Retinal fundus photograph.
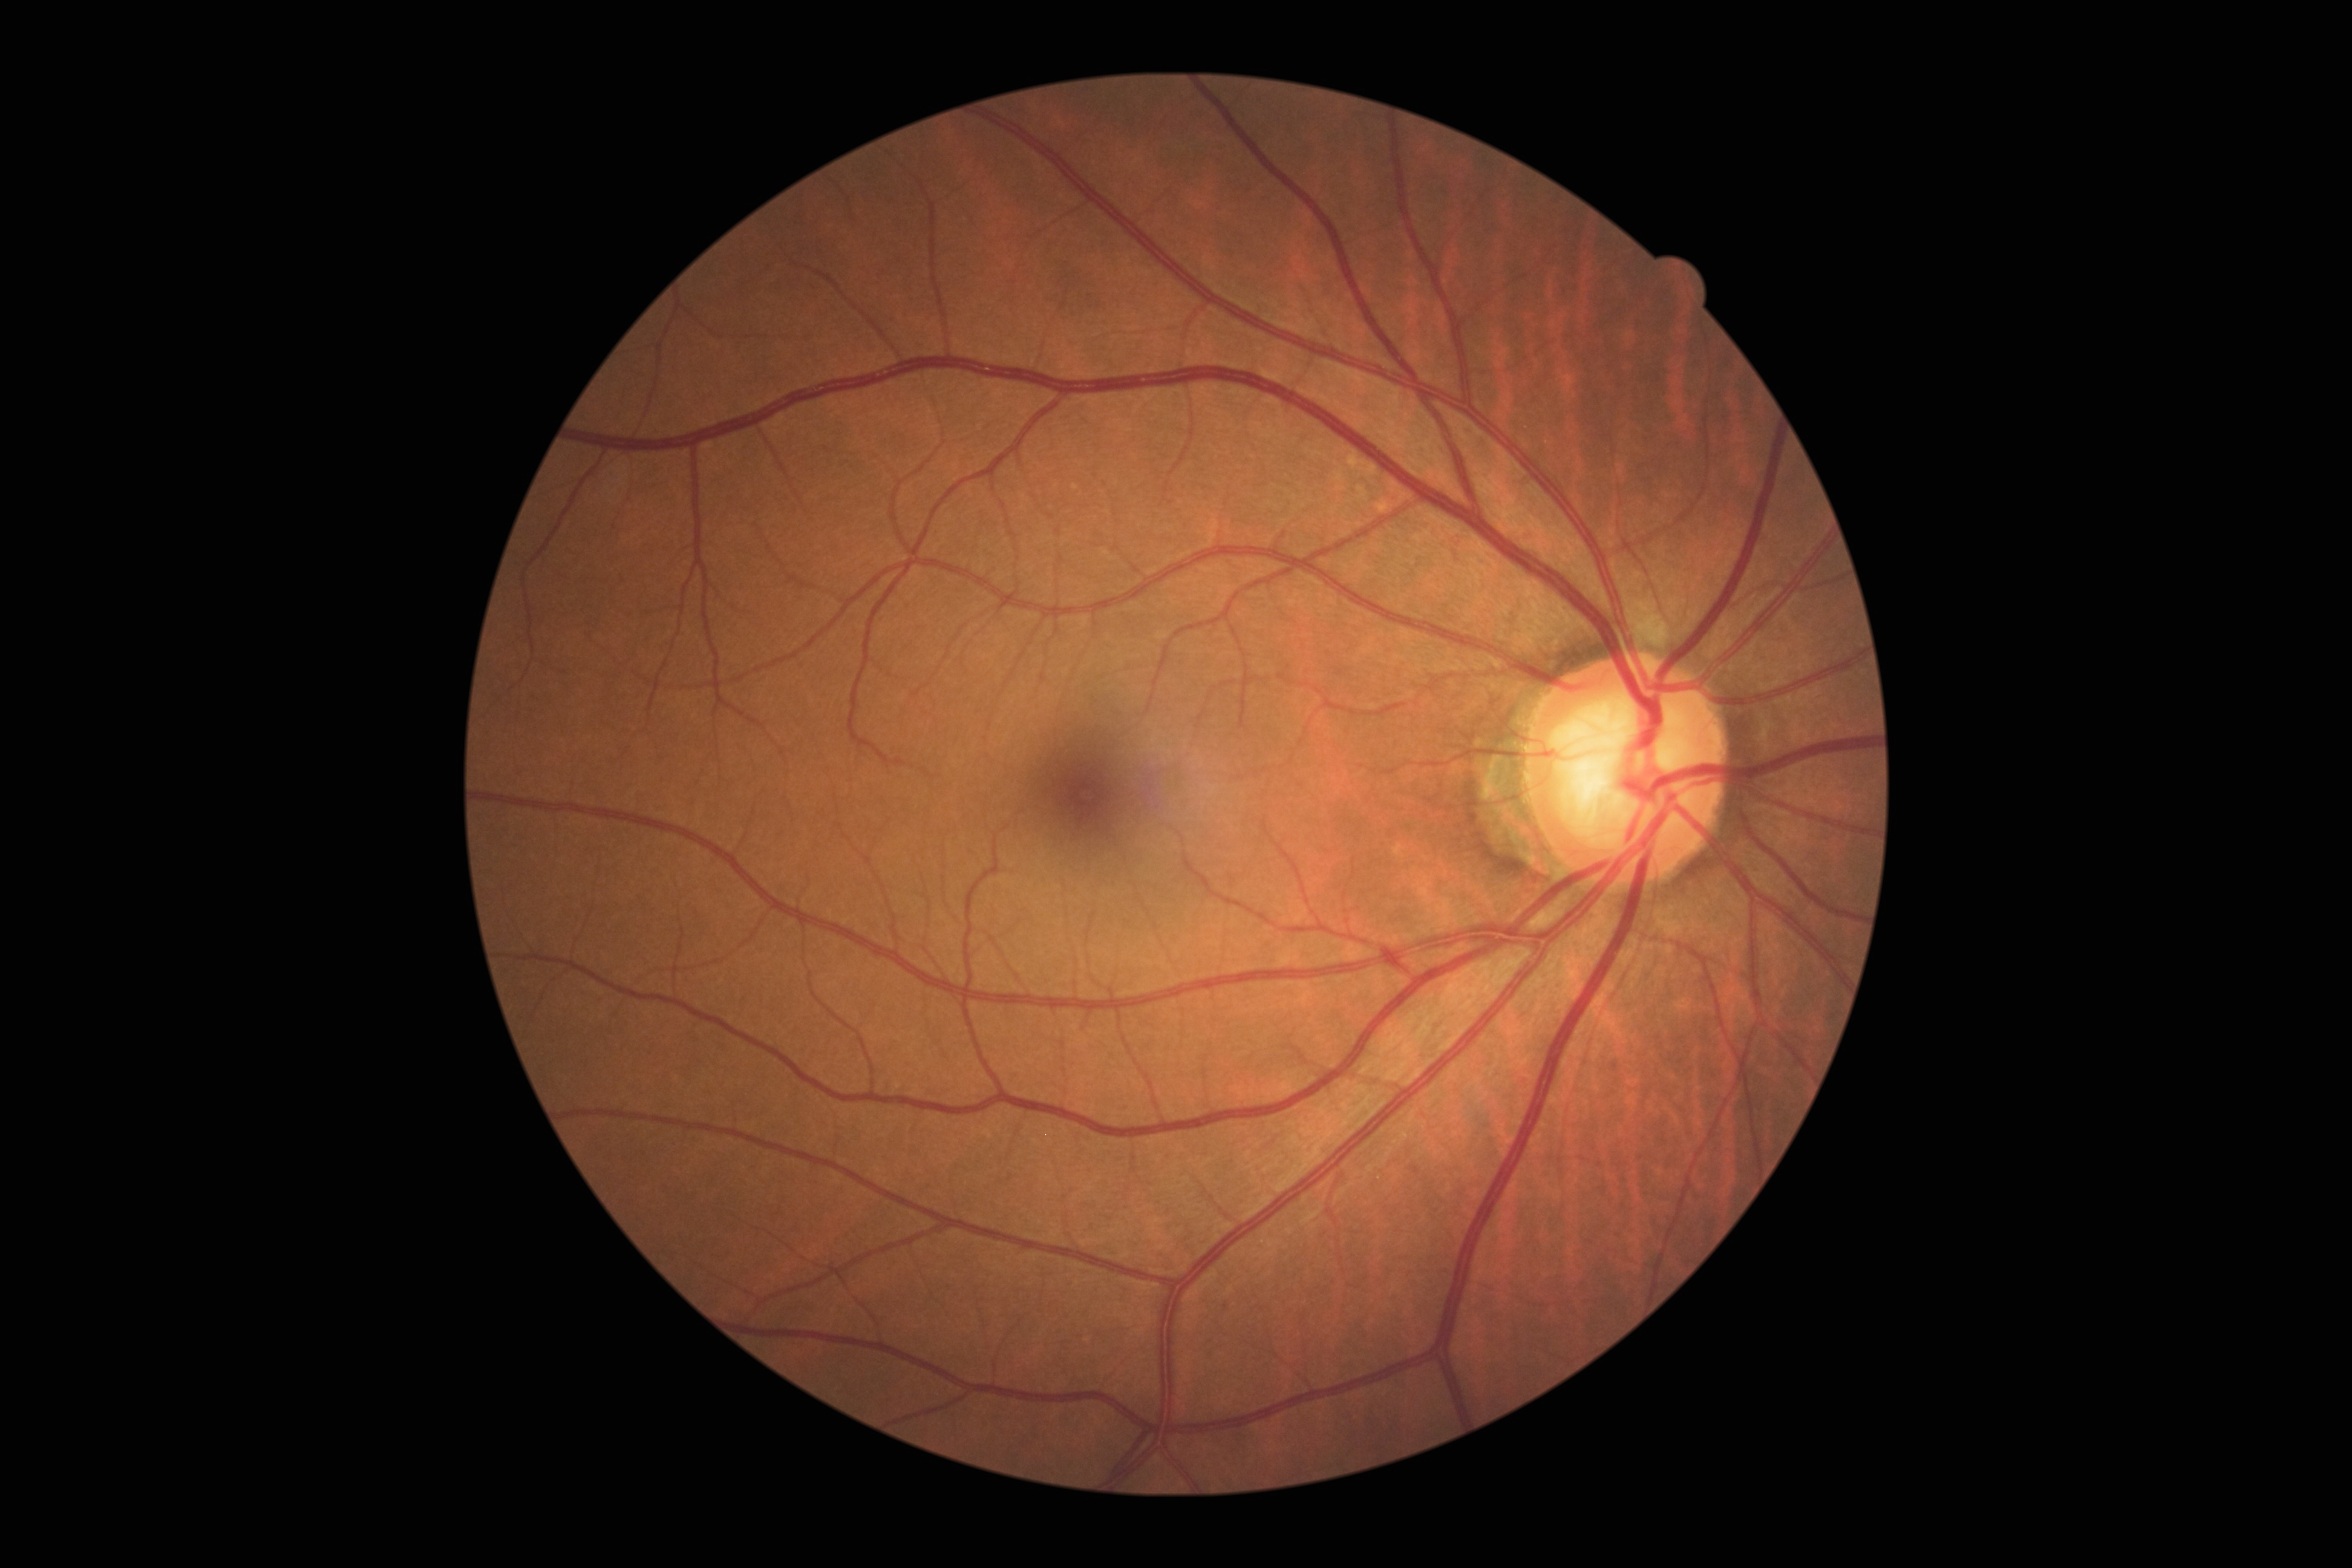

diabetic retinopathy (DR): 0/4 — no visible signs of diabetic retinopathy.